Color fundus photograph
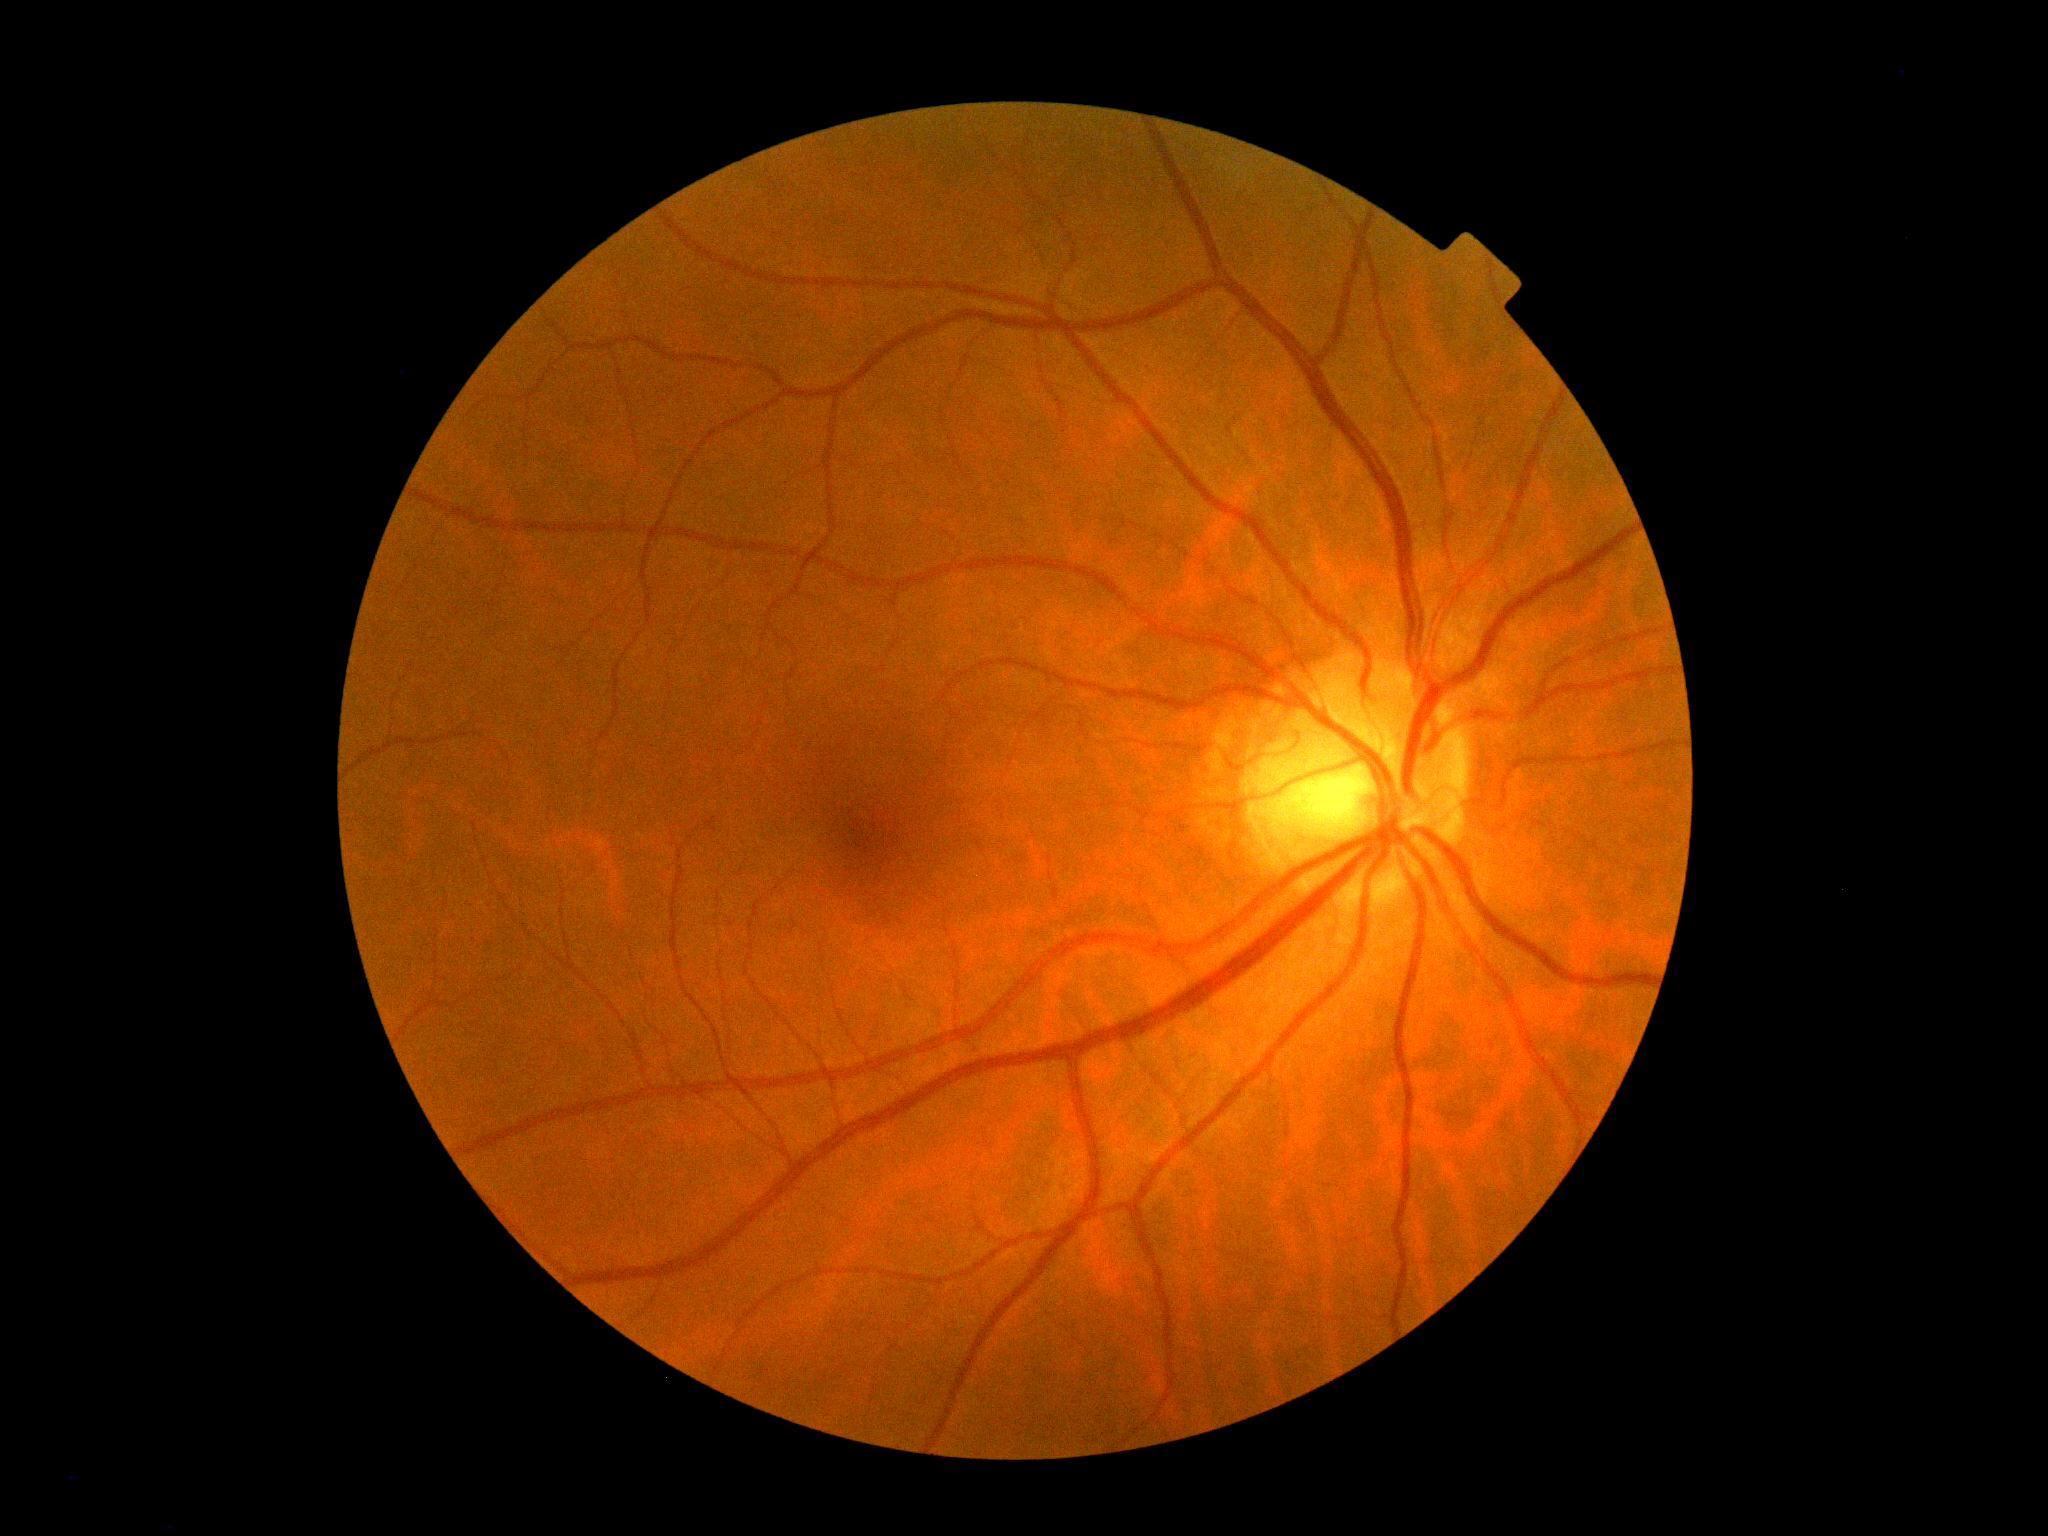
diabetic retinopathy: grade 0 (no apparent retinopathy).